Retinal fundus photograph:
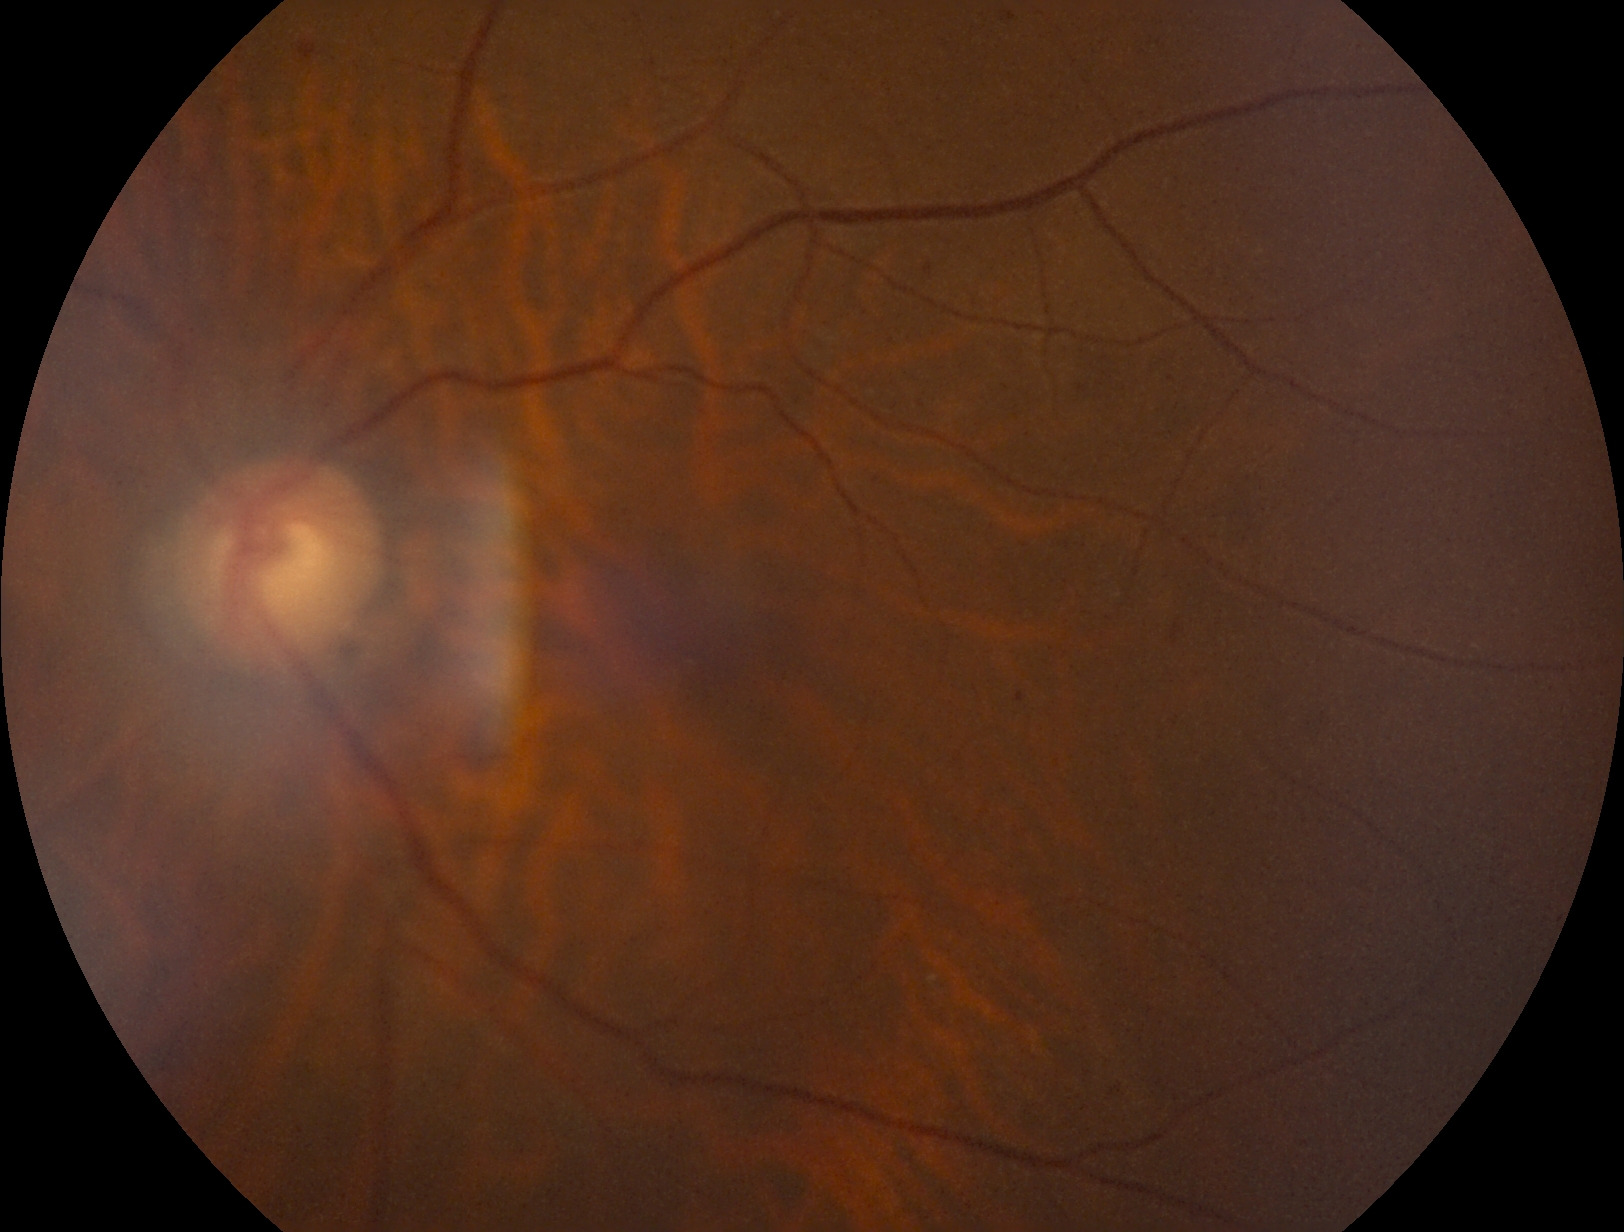
DR stage is mild non-proliferative diabetic retinopathy (grade 1) — presence of microaneurysms only.